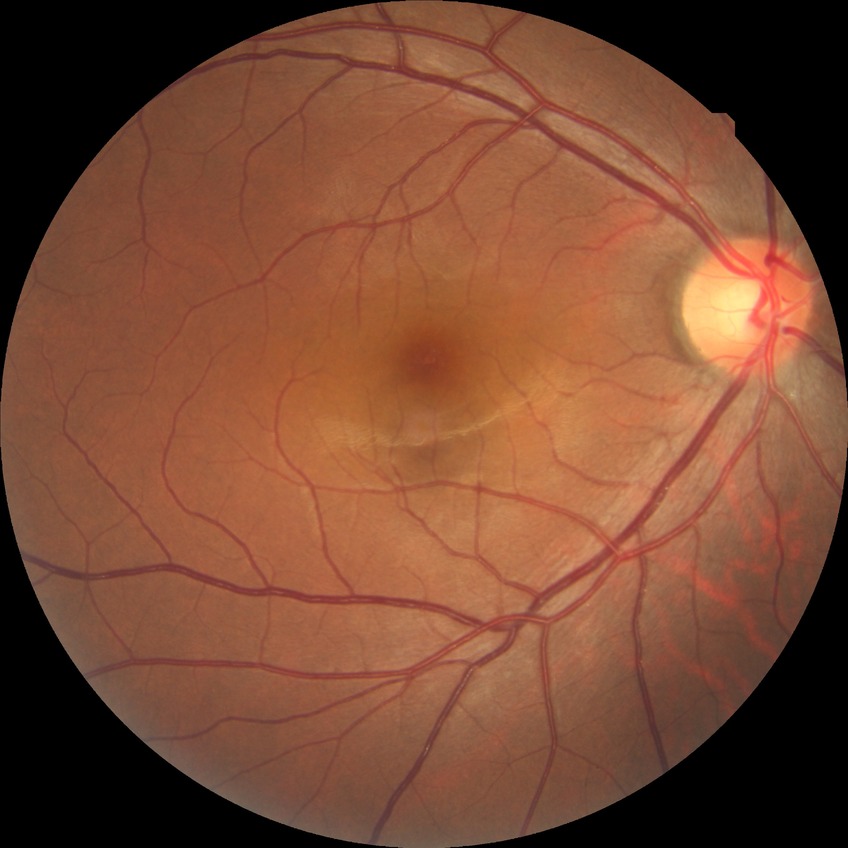 Assessment:
* modified Davis grade — NDR